Color fundus photograph · Remidio smartphone fundus camera: 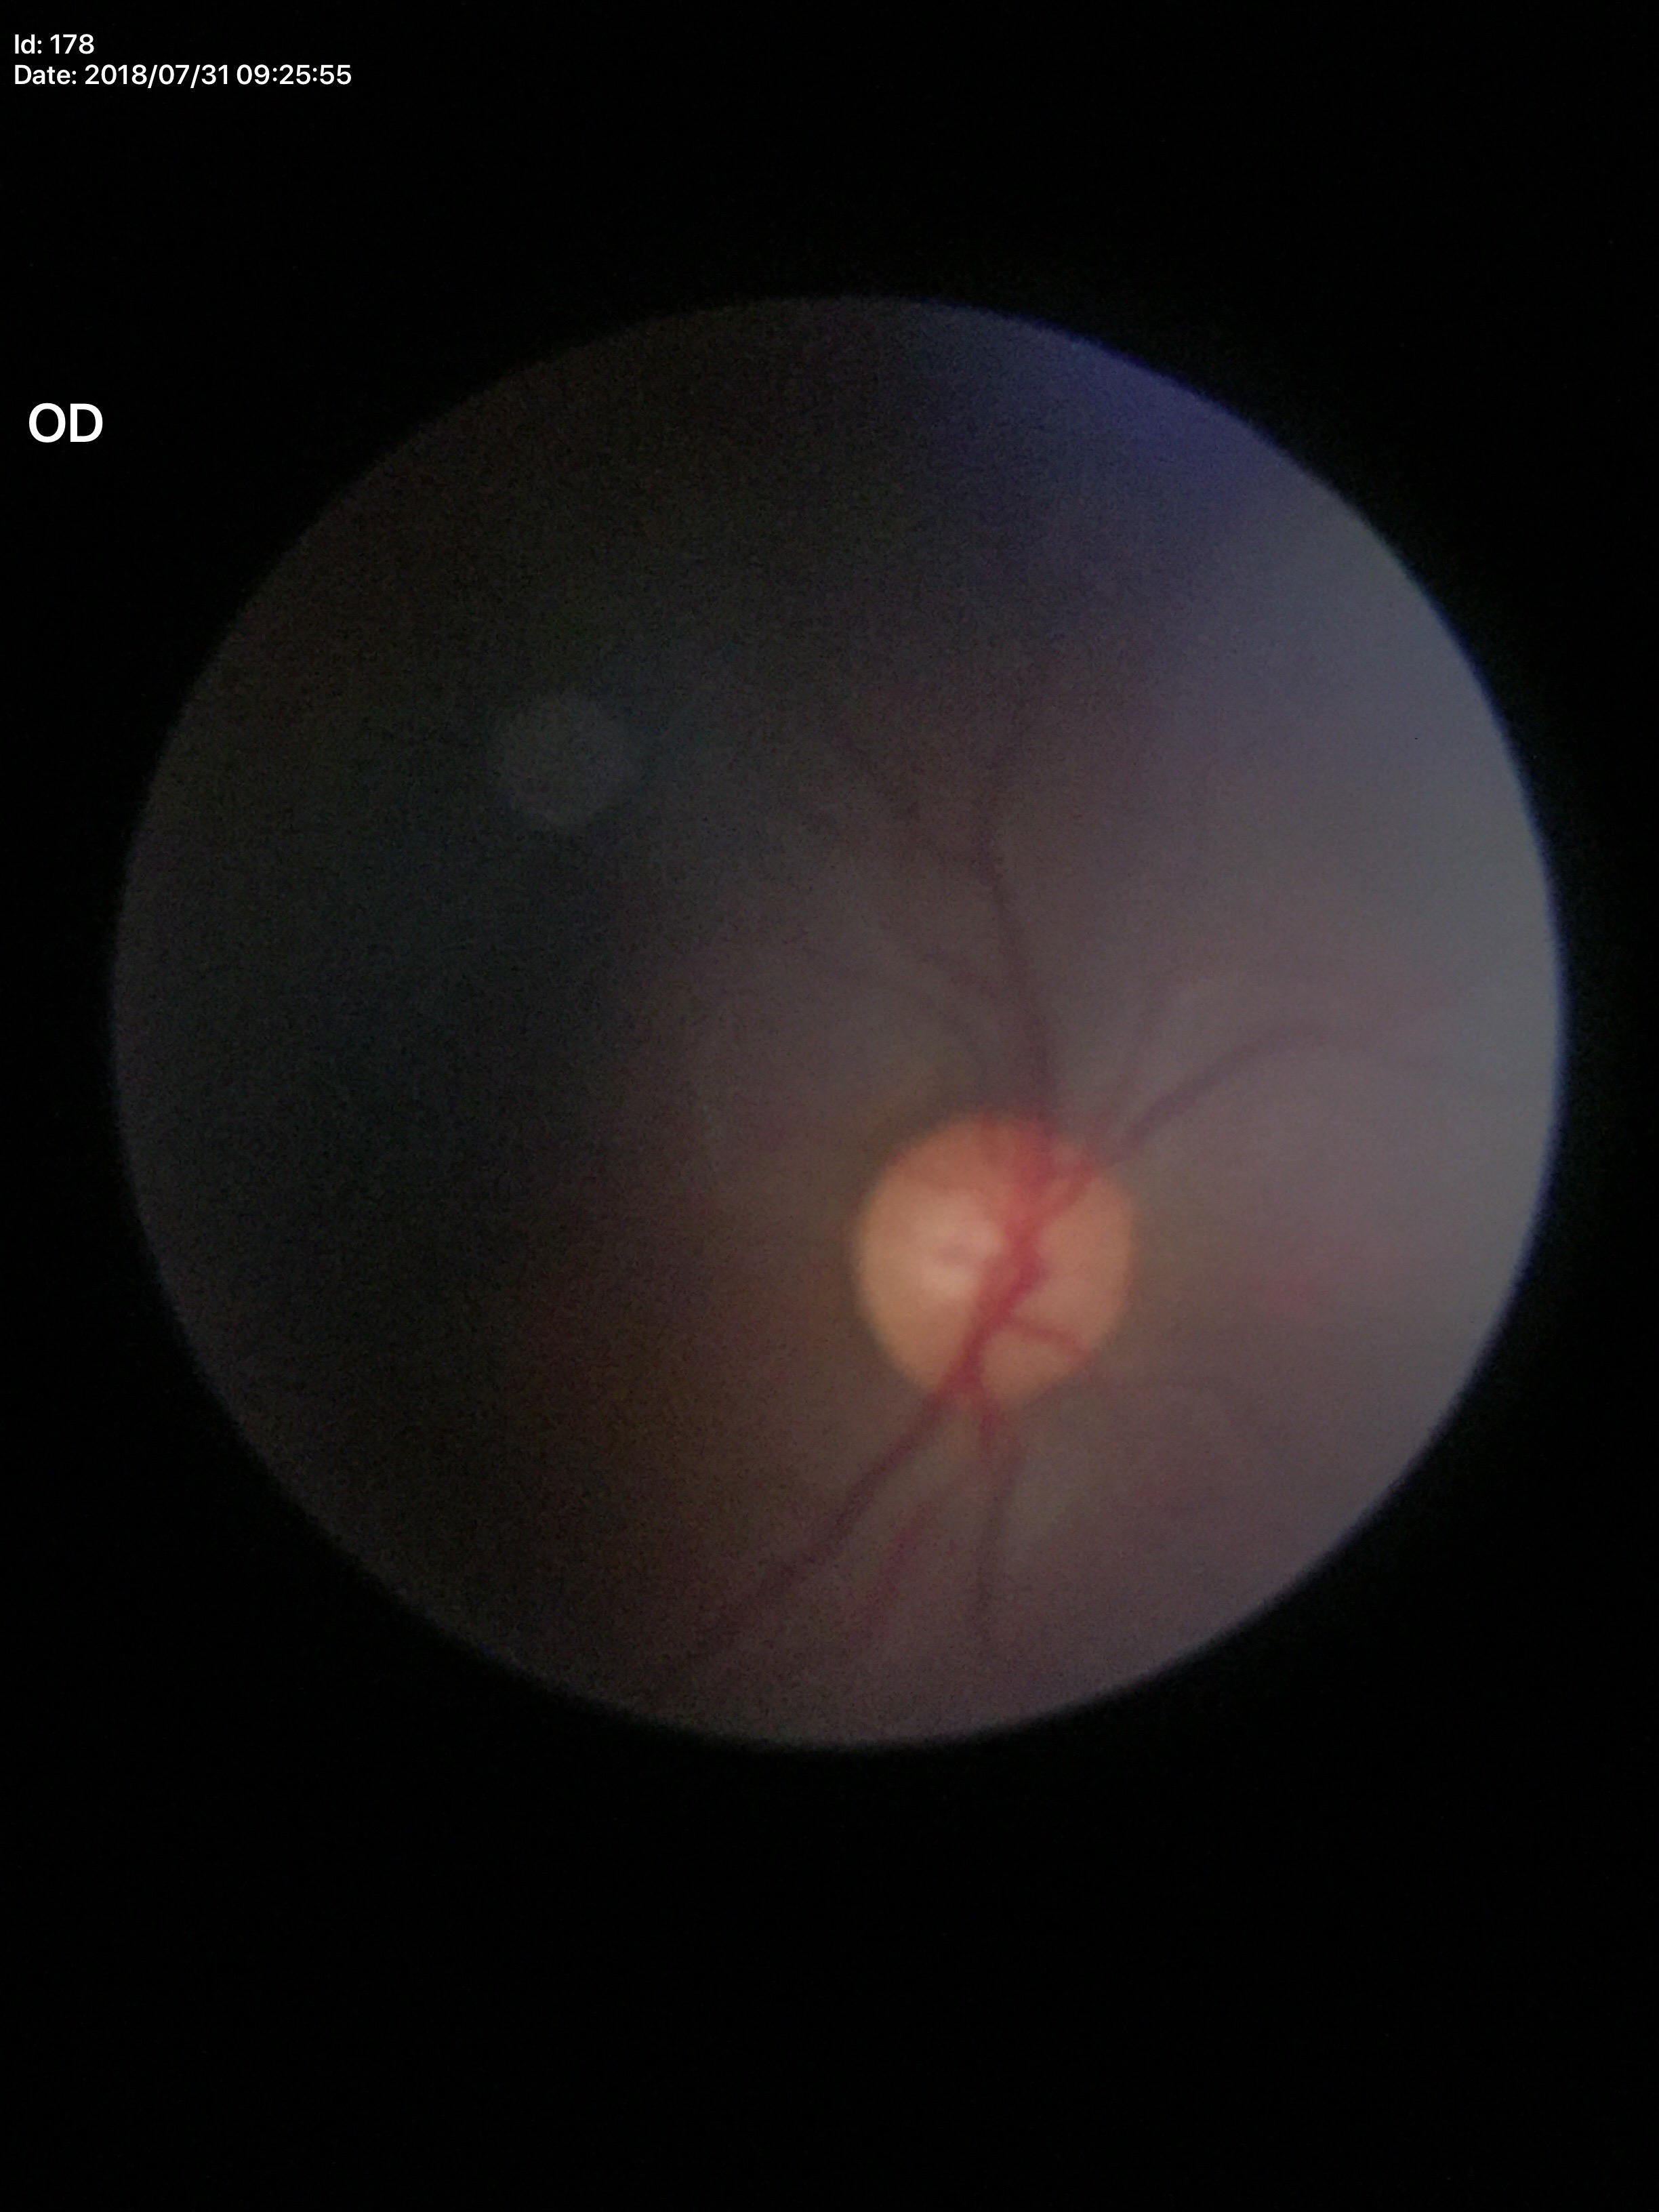

Q: Is there glaucoma suspicion?
A: negative
Q: What is the VCDR?
A: 0.53